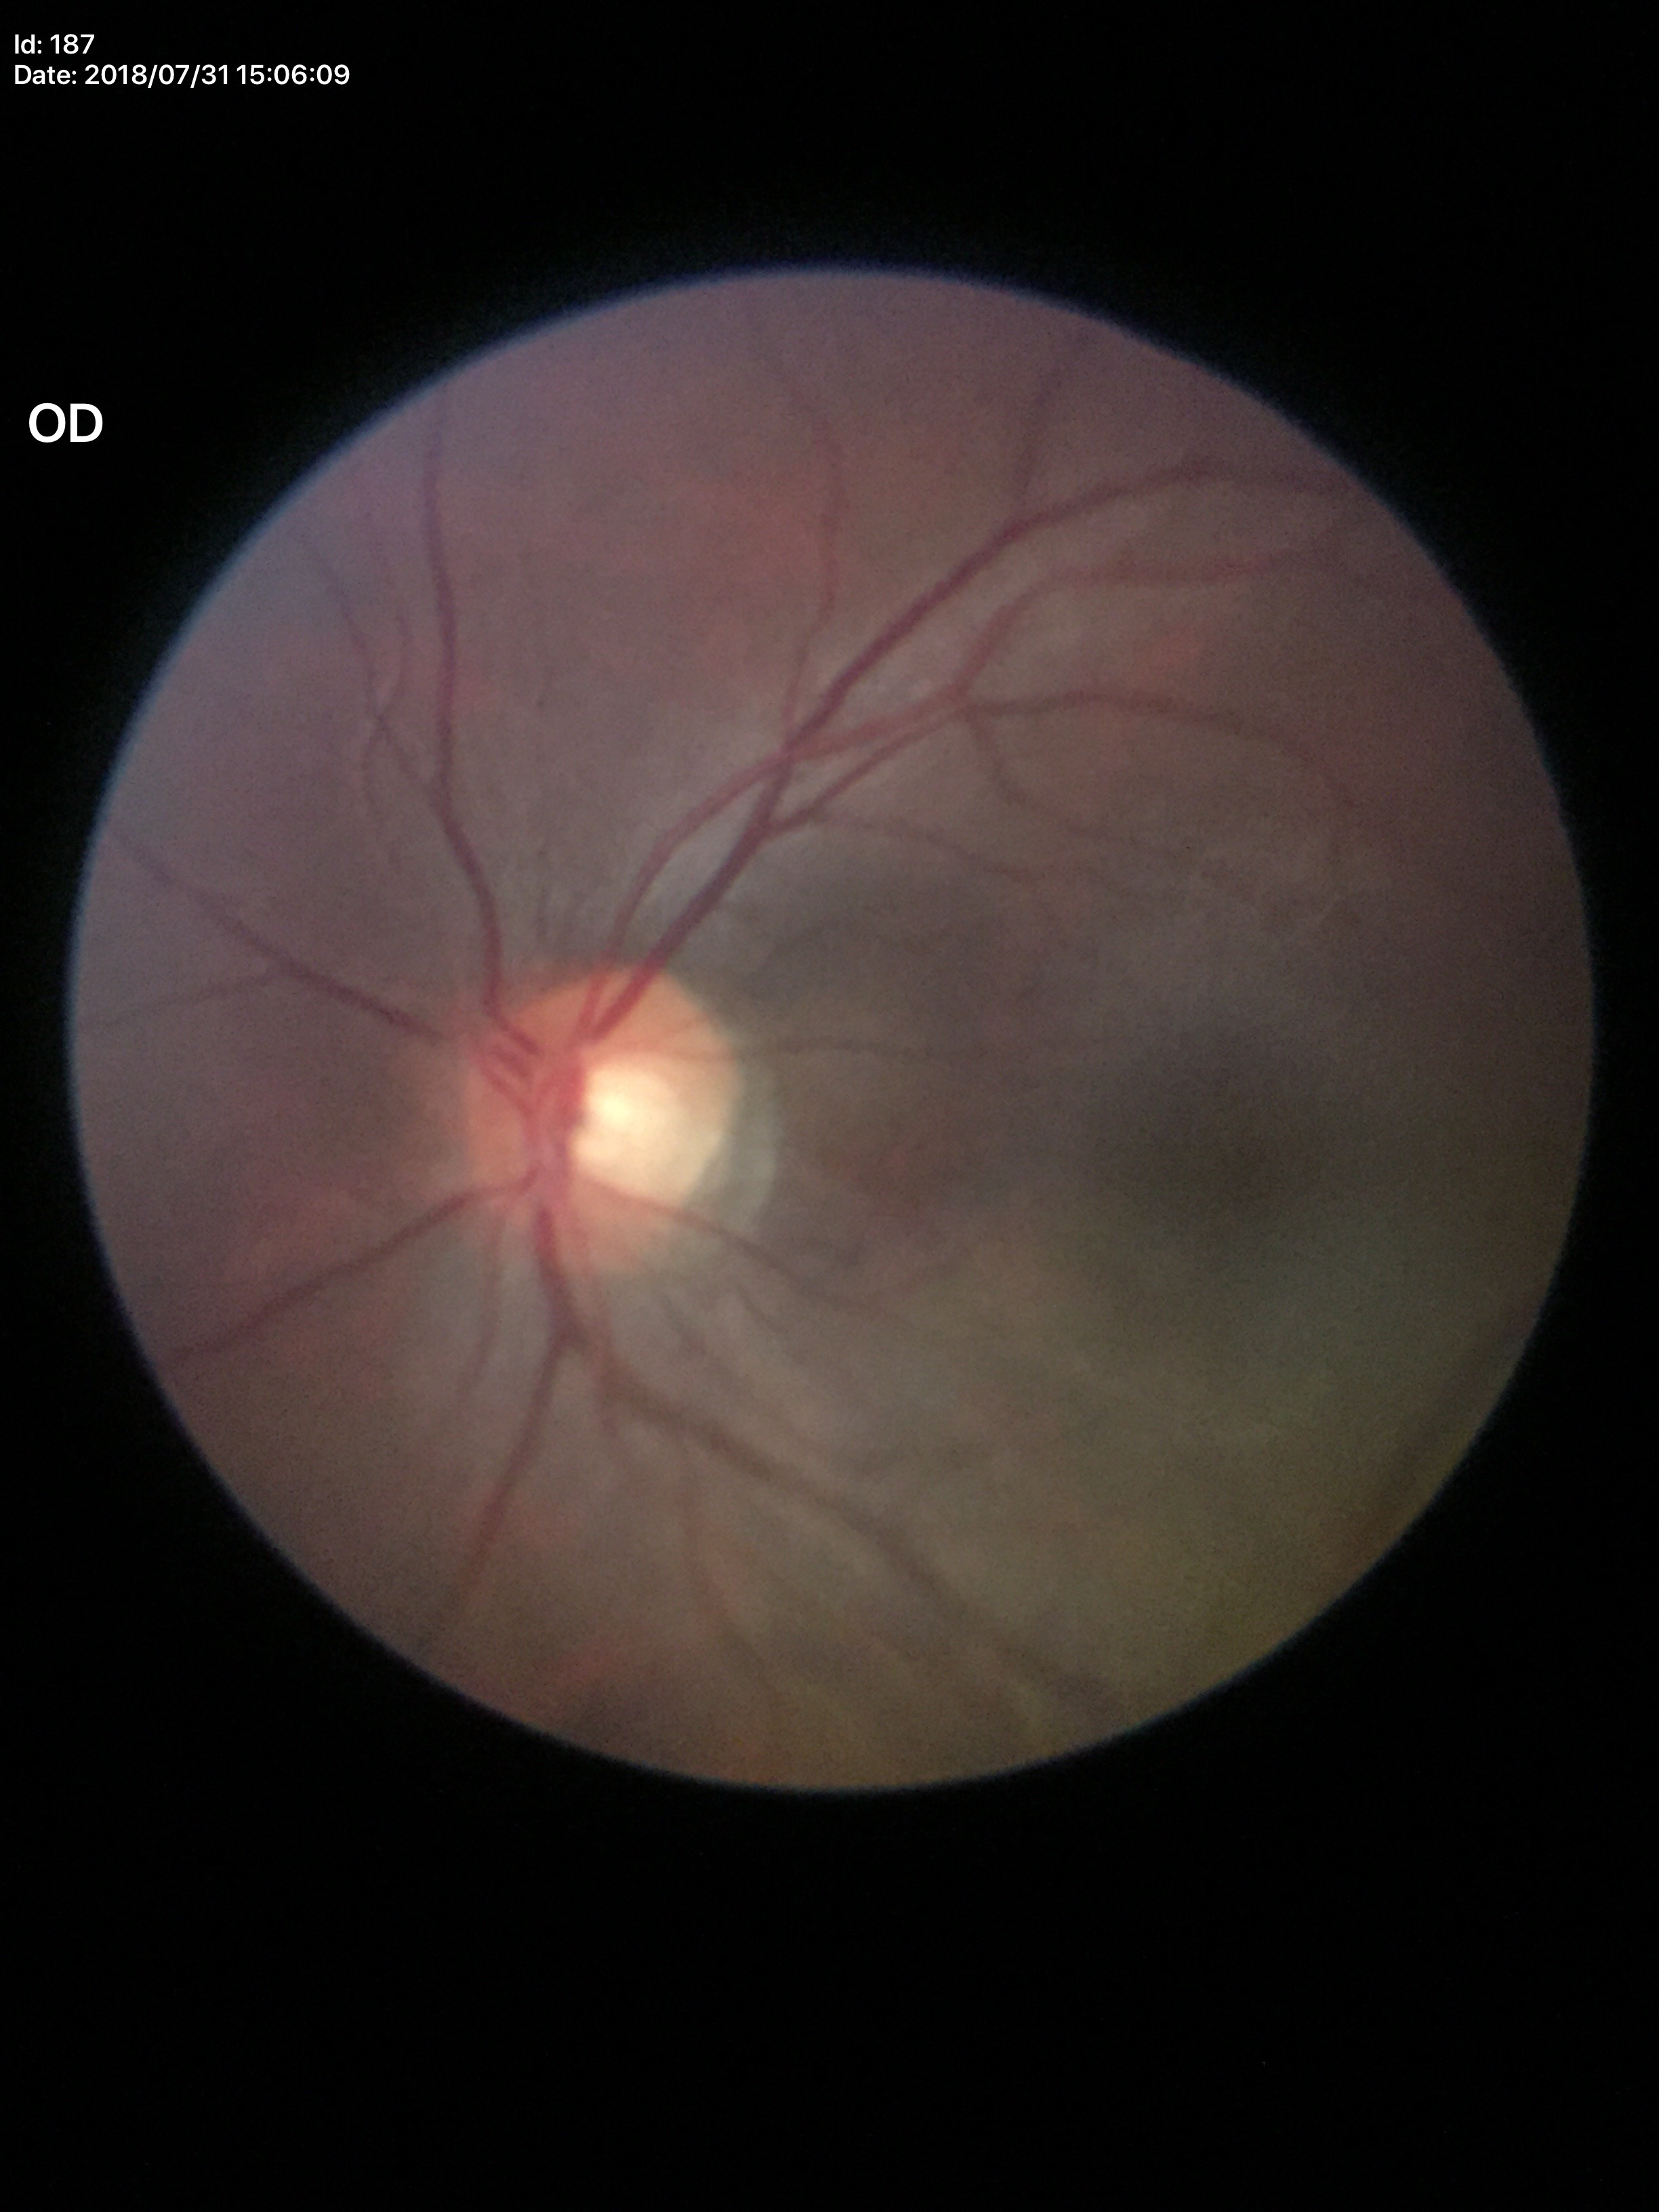
Glaucoma impression=not suspect | vertical C/D ratio (VCDR)=0.55